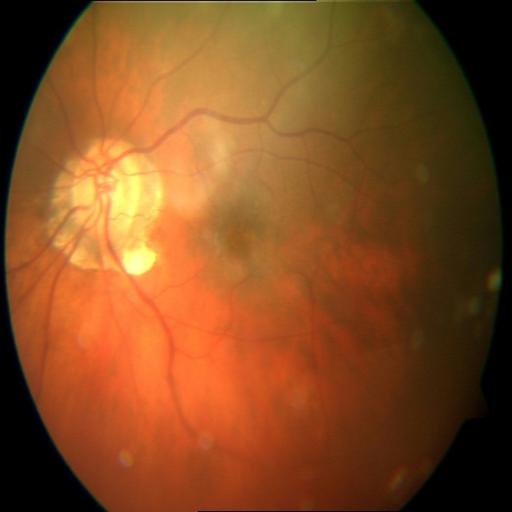

2 findings. Showing myopia & optic disc cupping.